Image size 349x349; fundus photograph cropped around the optic nerve head: 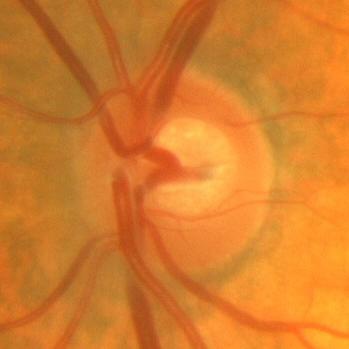

The image shows no glaucomatous findings.